Posterior pole photograph, 848x848px, 45-degree field of view.
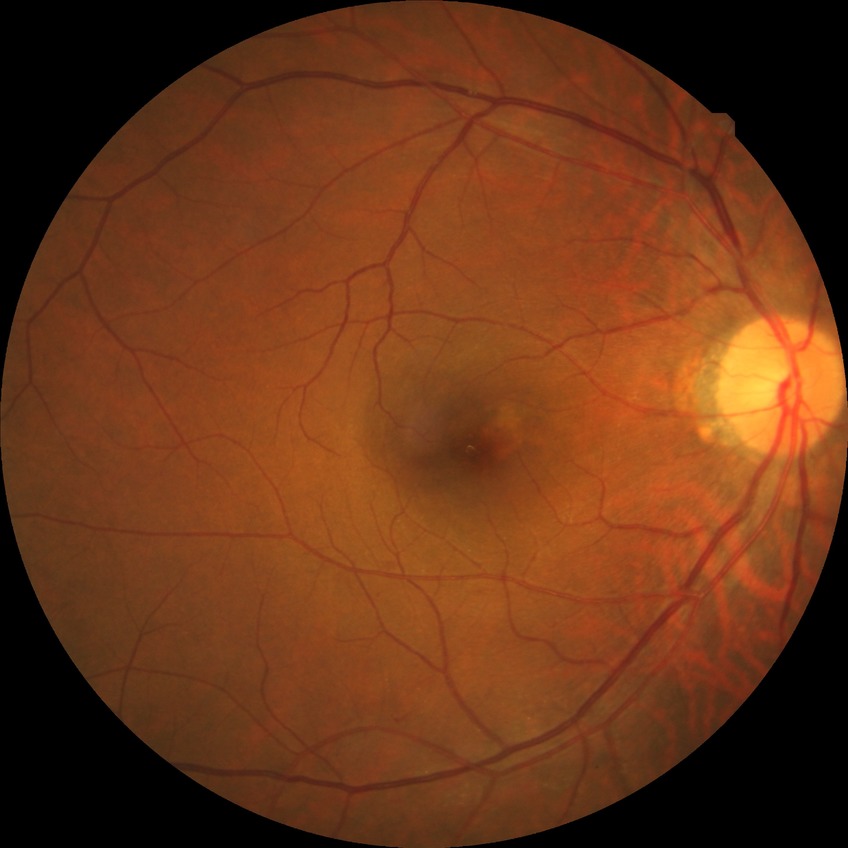

Diabetic retinopathy stage: no diabetic retinopathy.